1932 by 1932 pixels. 45° FOV. Retinal fundus photograph — 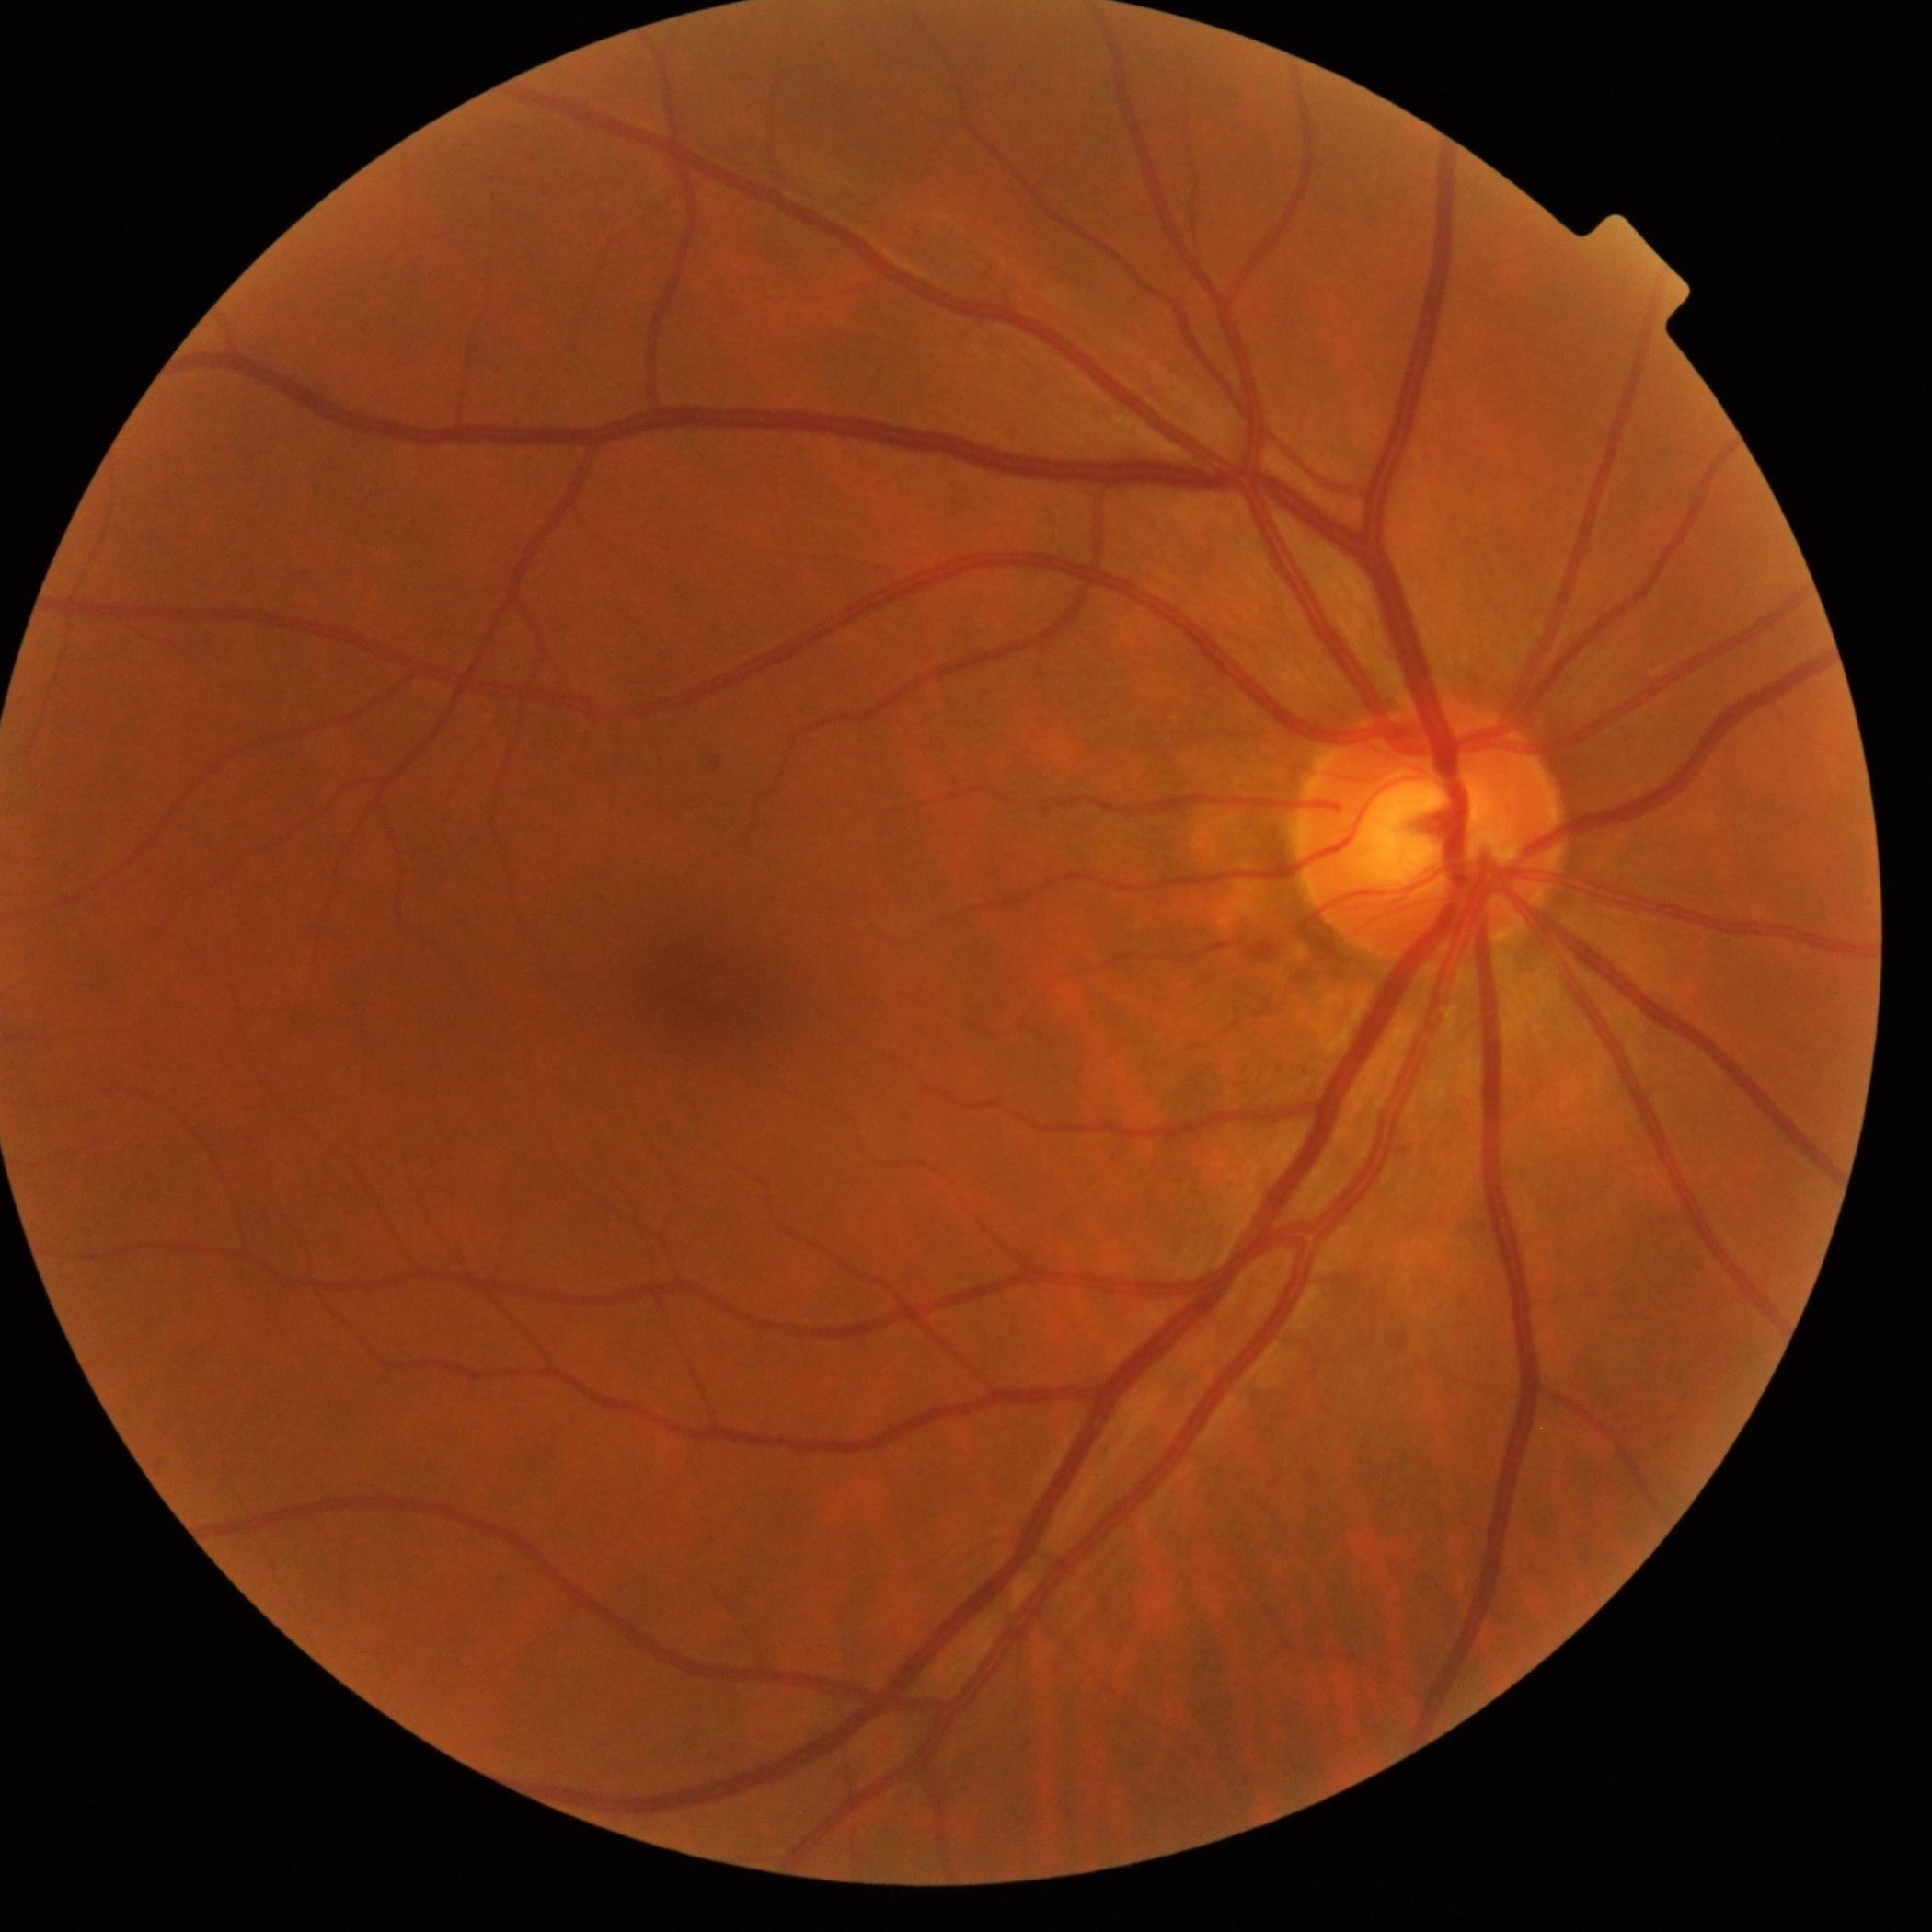
DR grade is 0.